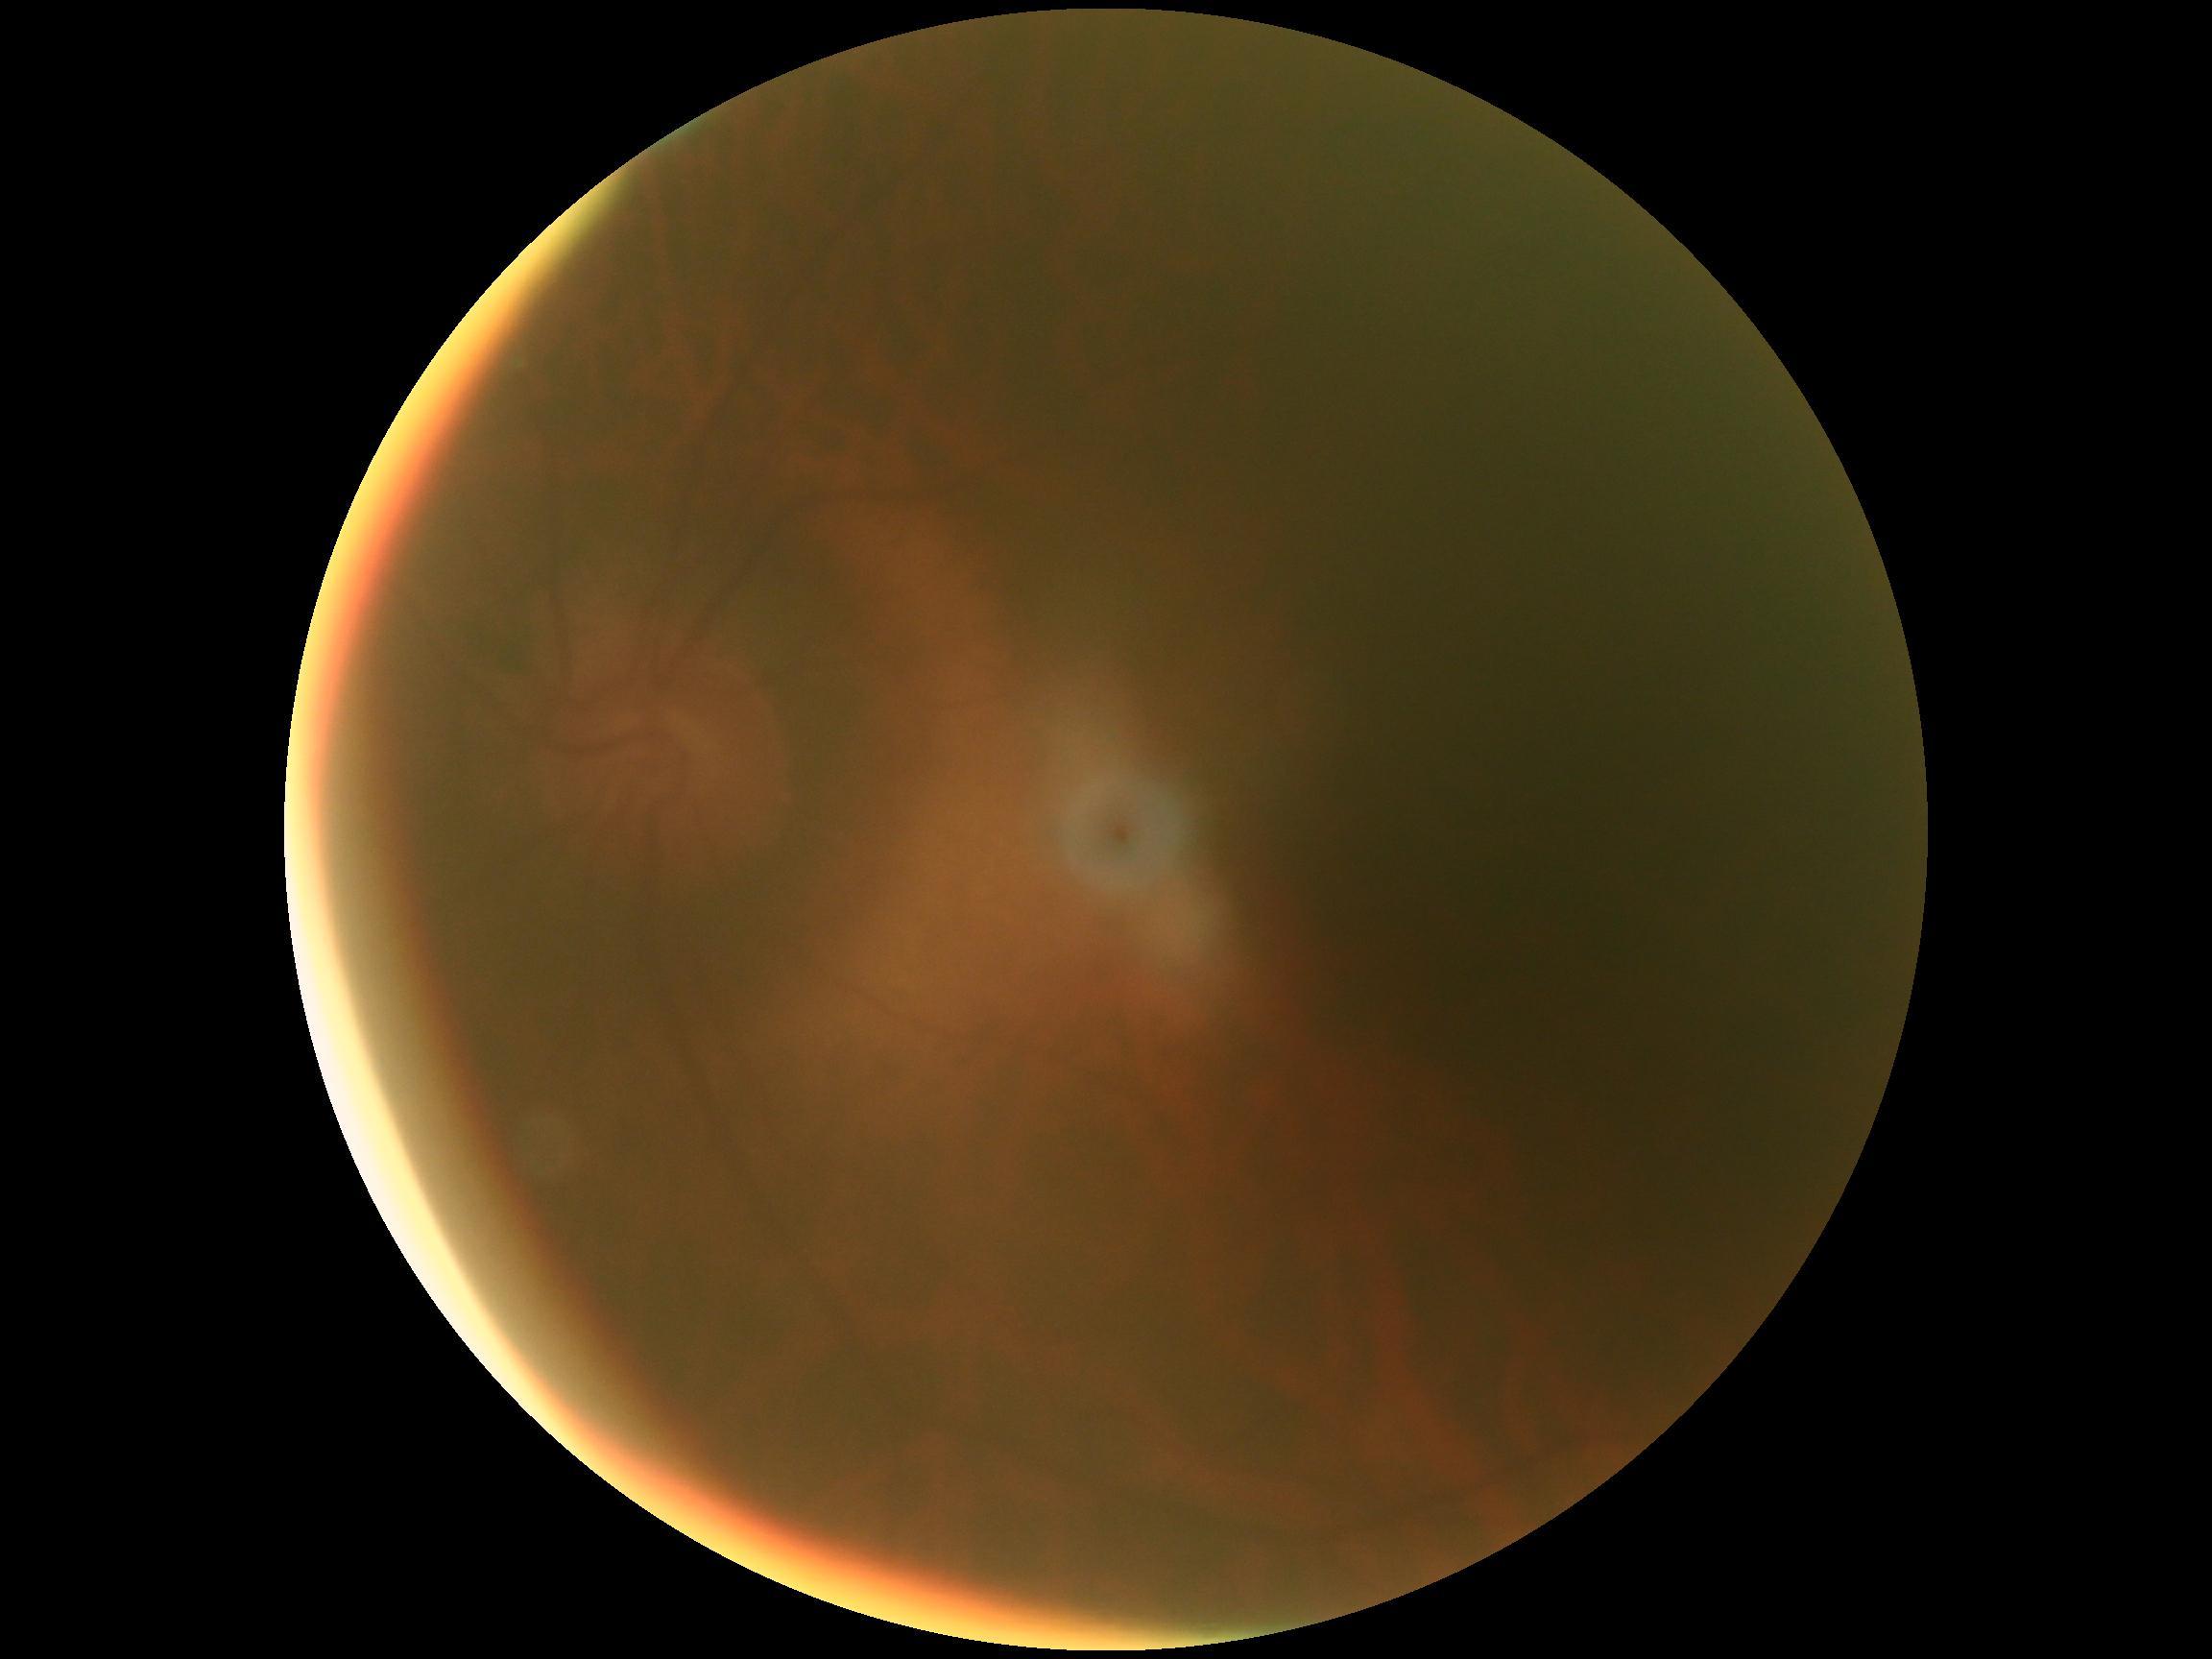 diabetic retinopathy severity=ungradable.